Color fundus photograph, 2048 x 1536 pixels, 45° field of view
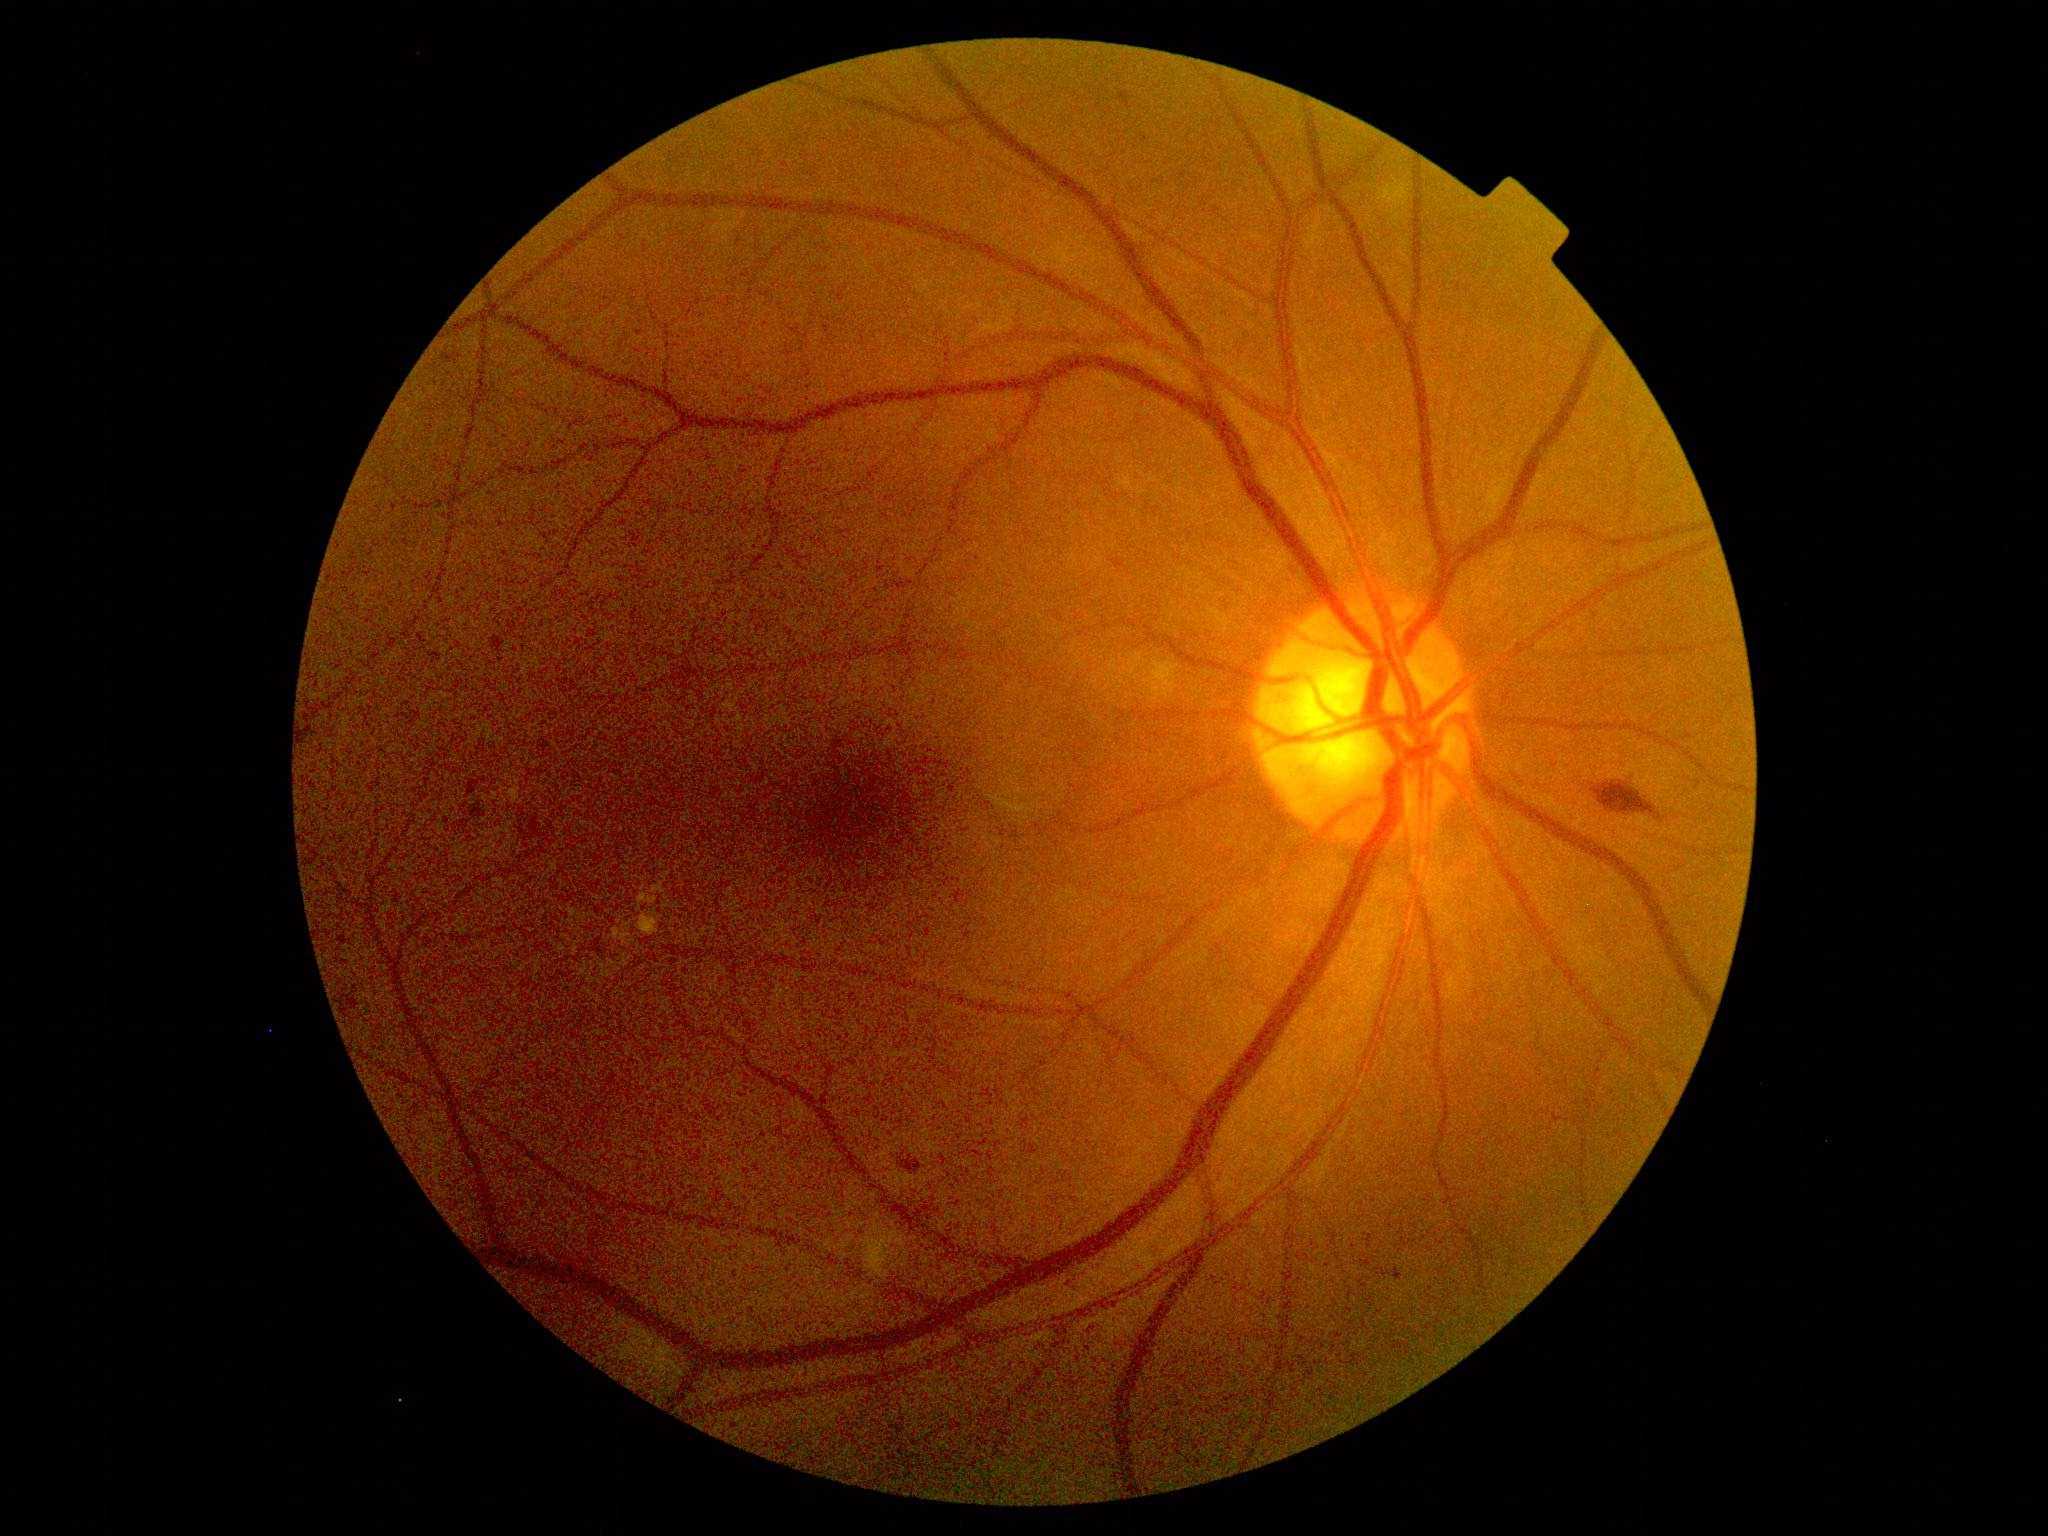

Diabetic retinopathy grade: 2 (moderate NPDR) — more than just microaneurysms but less than severe NPDR.